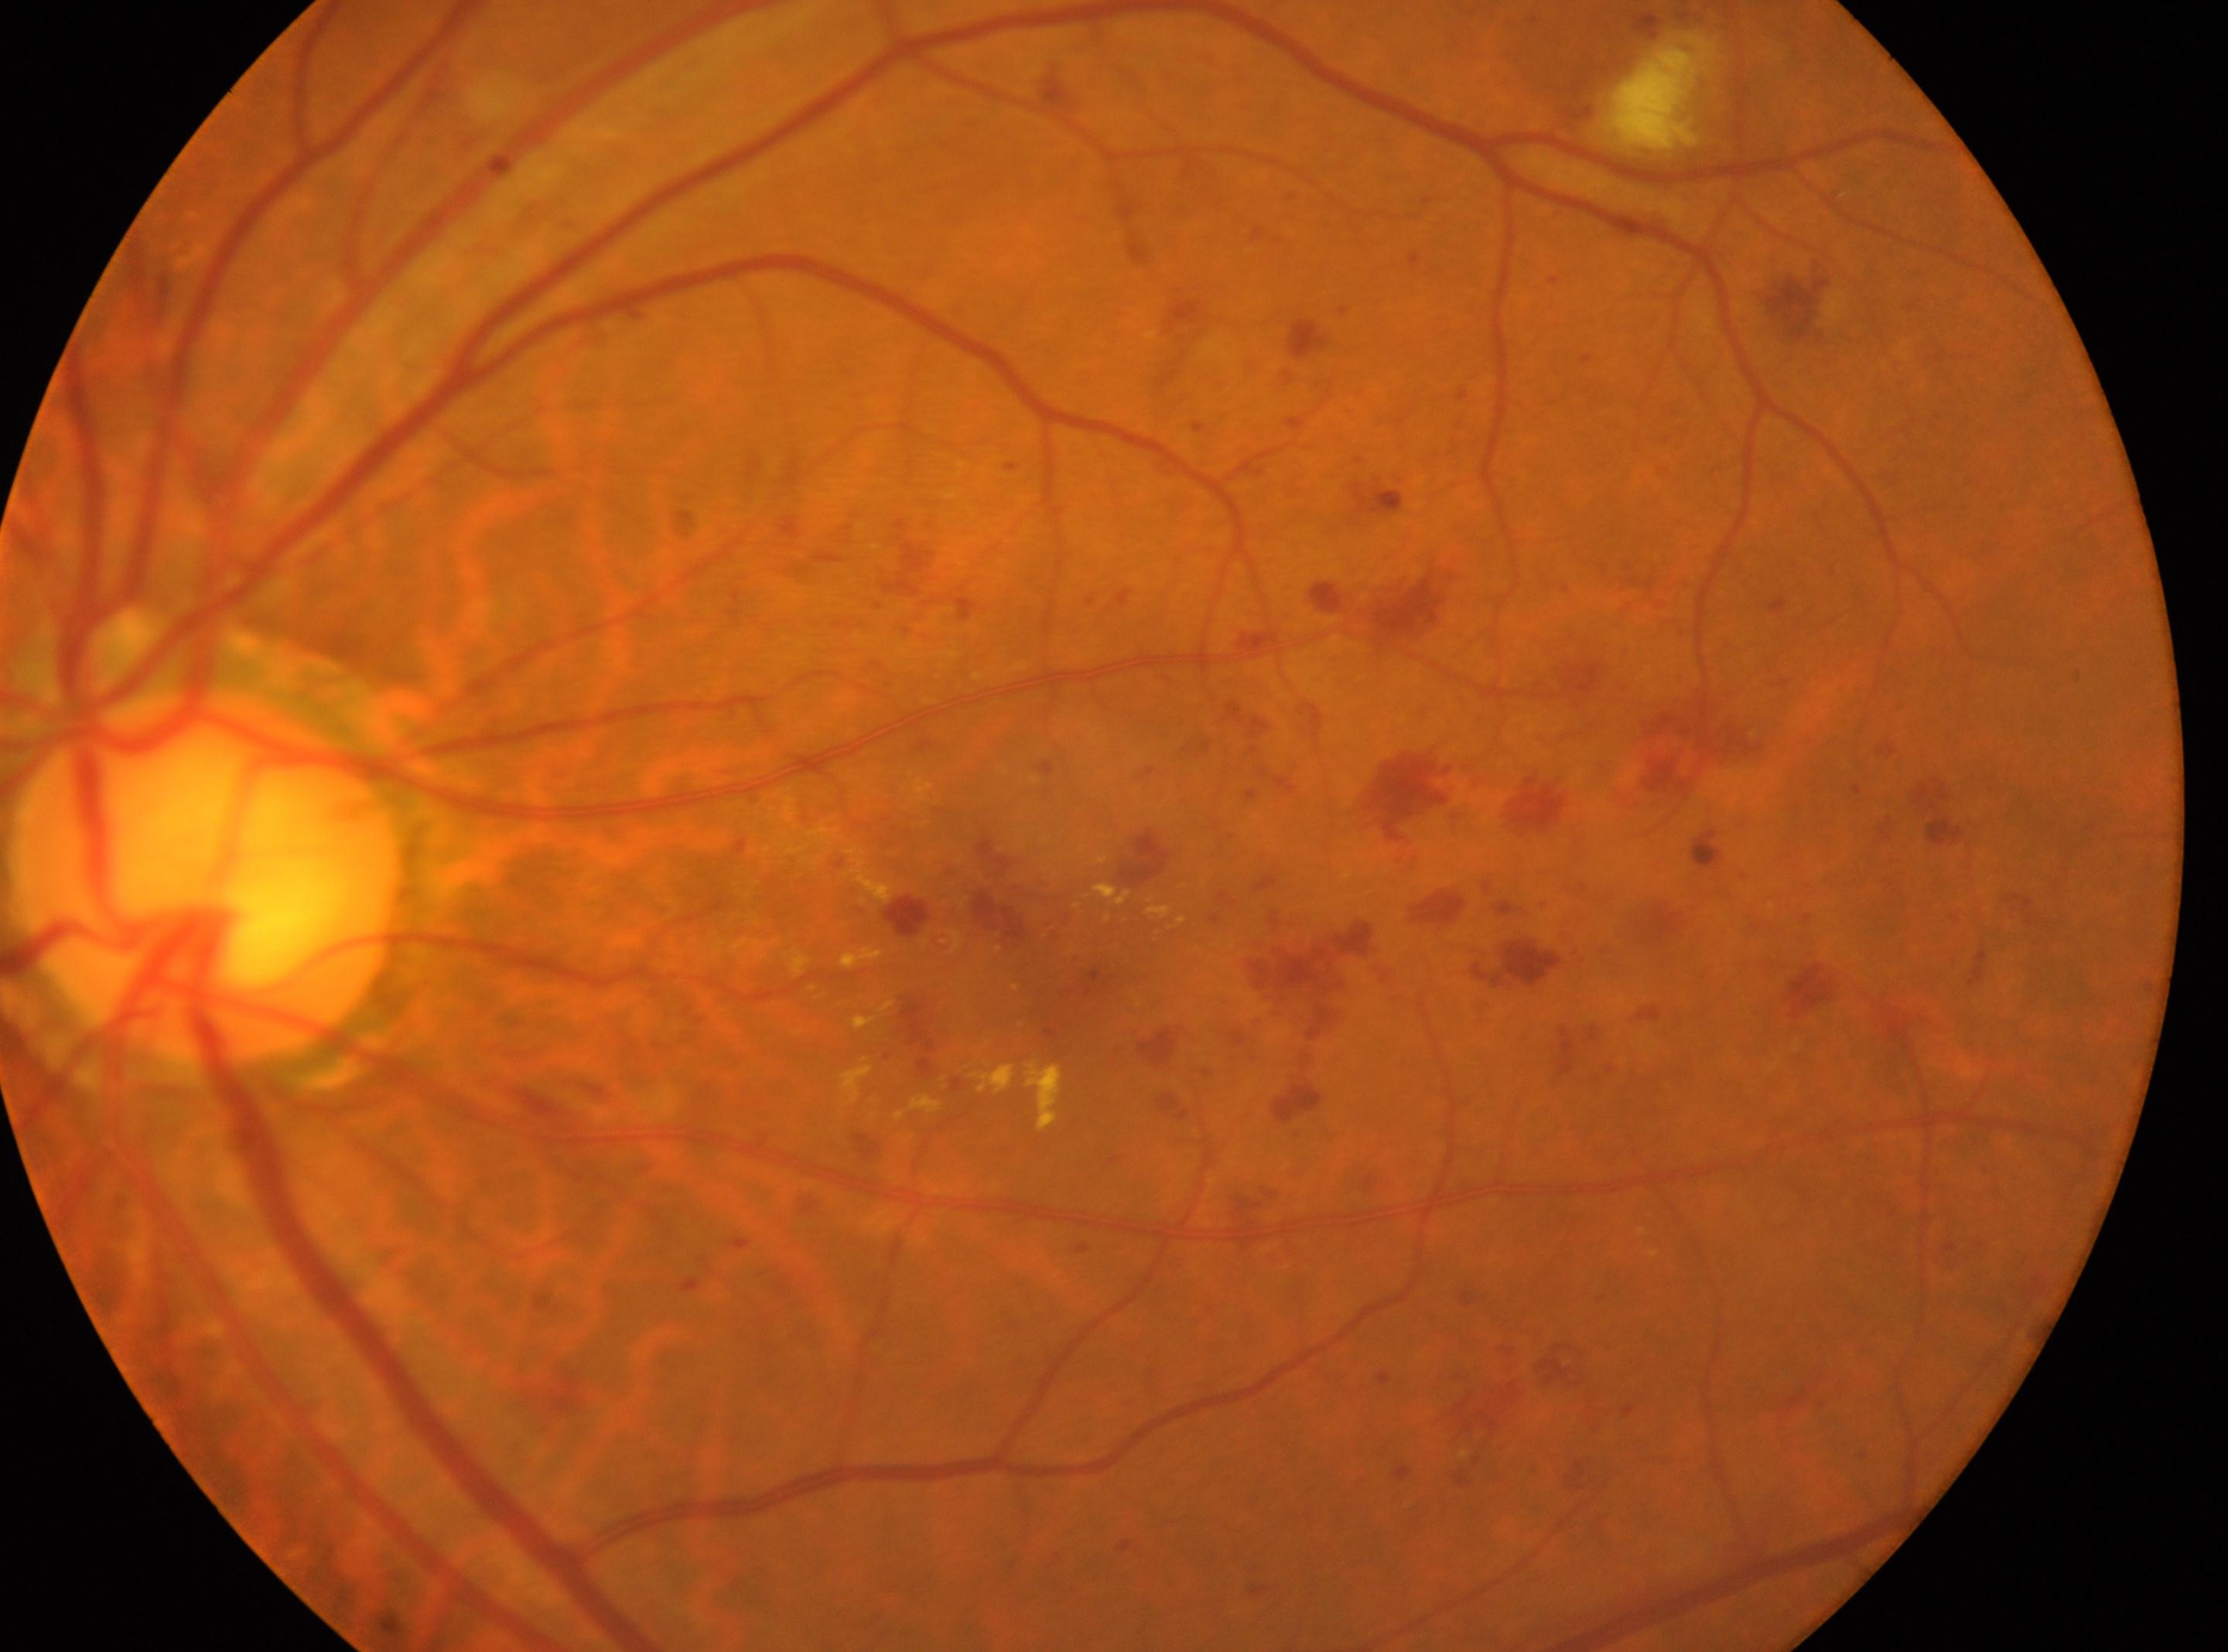

Eye: oculus sinister.
Diabetic retinopathy (DR): moderate NPDR (grade 2).
Disc center: [209, 875].
Macular center located at [1058, 940].